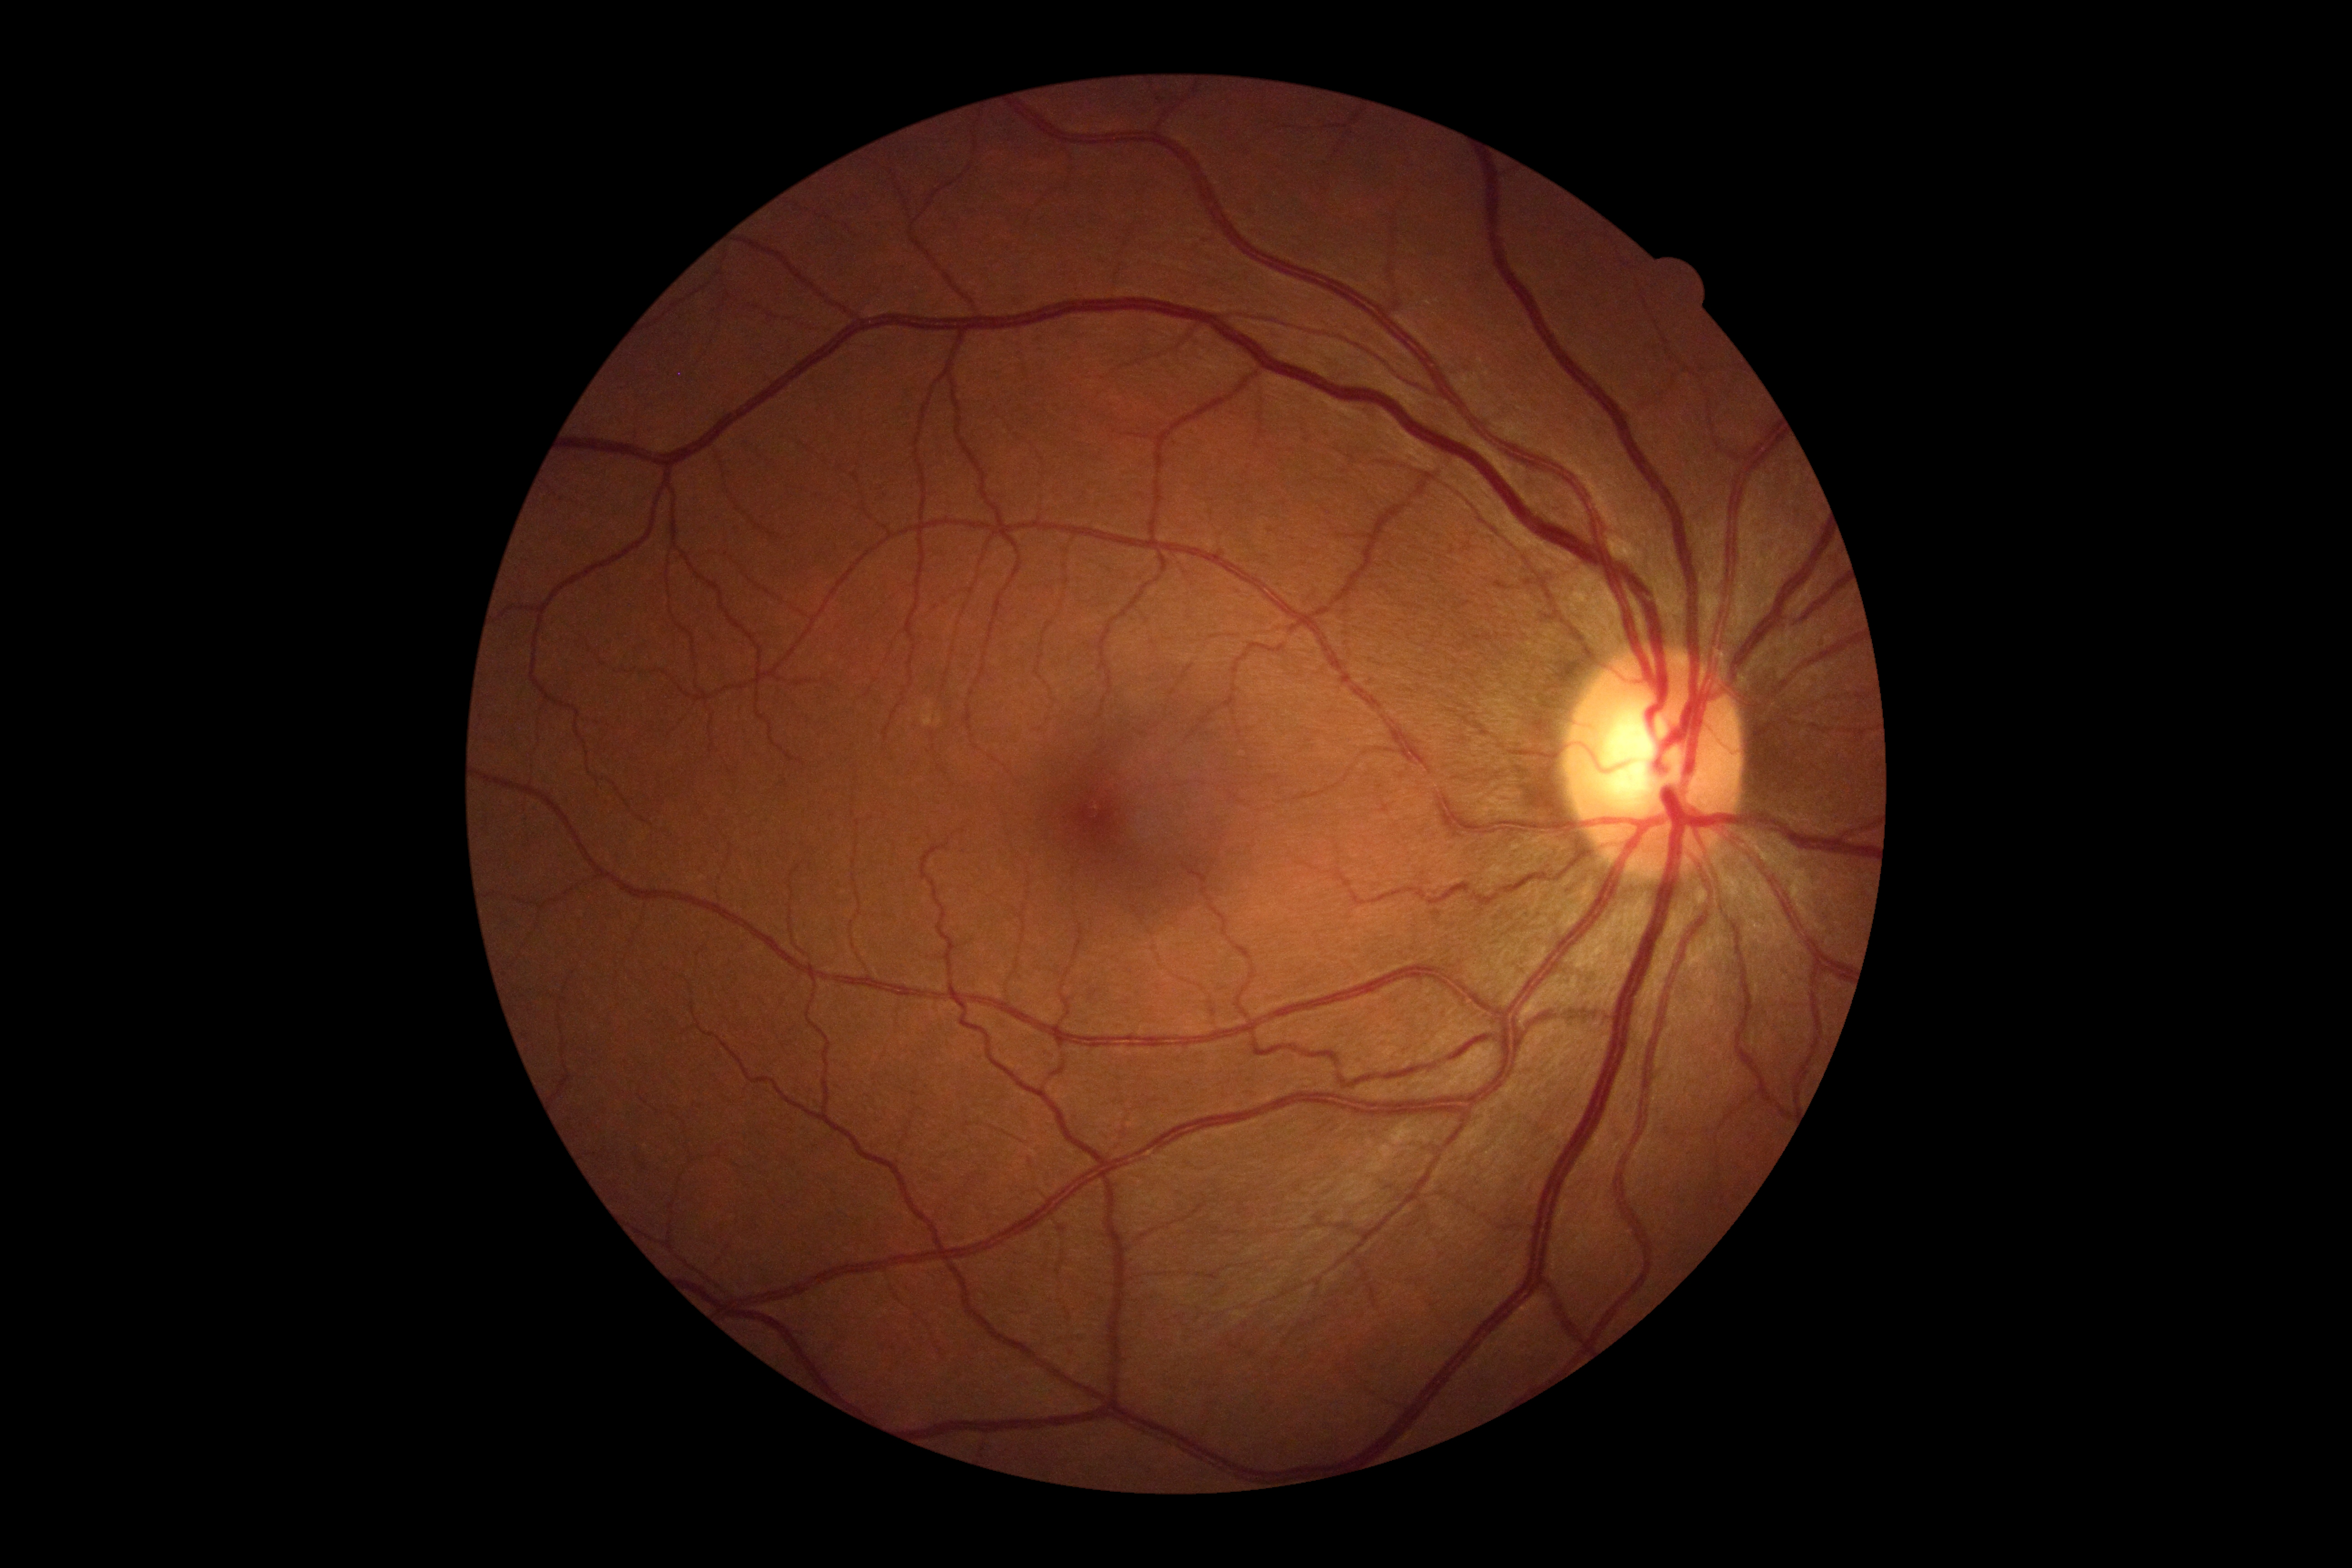
No diabetic retinal disease findings. DR: no apparent retinopathy (grade 0) — no visible signs of diabetic retinopathy.